45° FOV
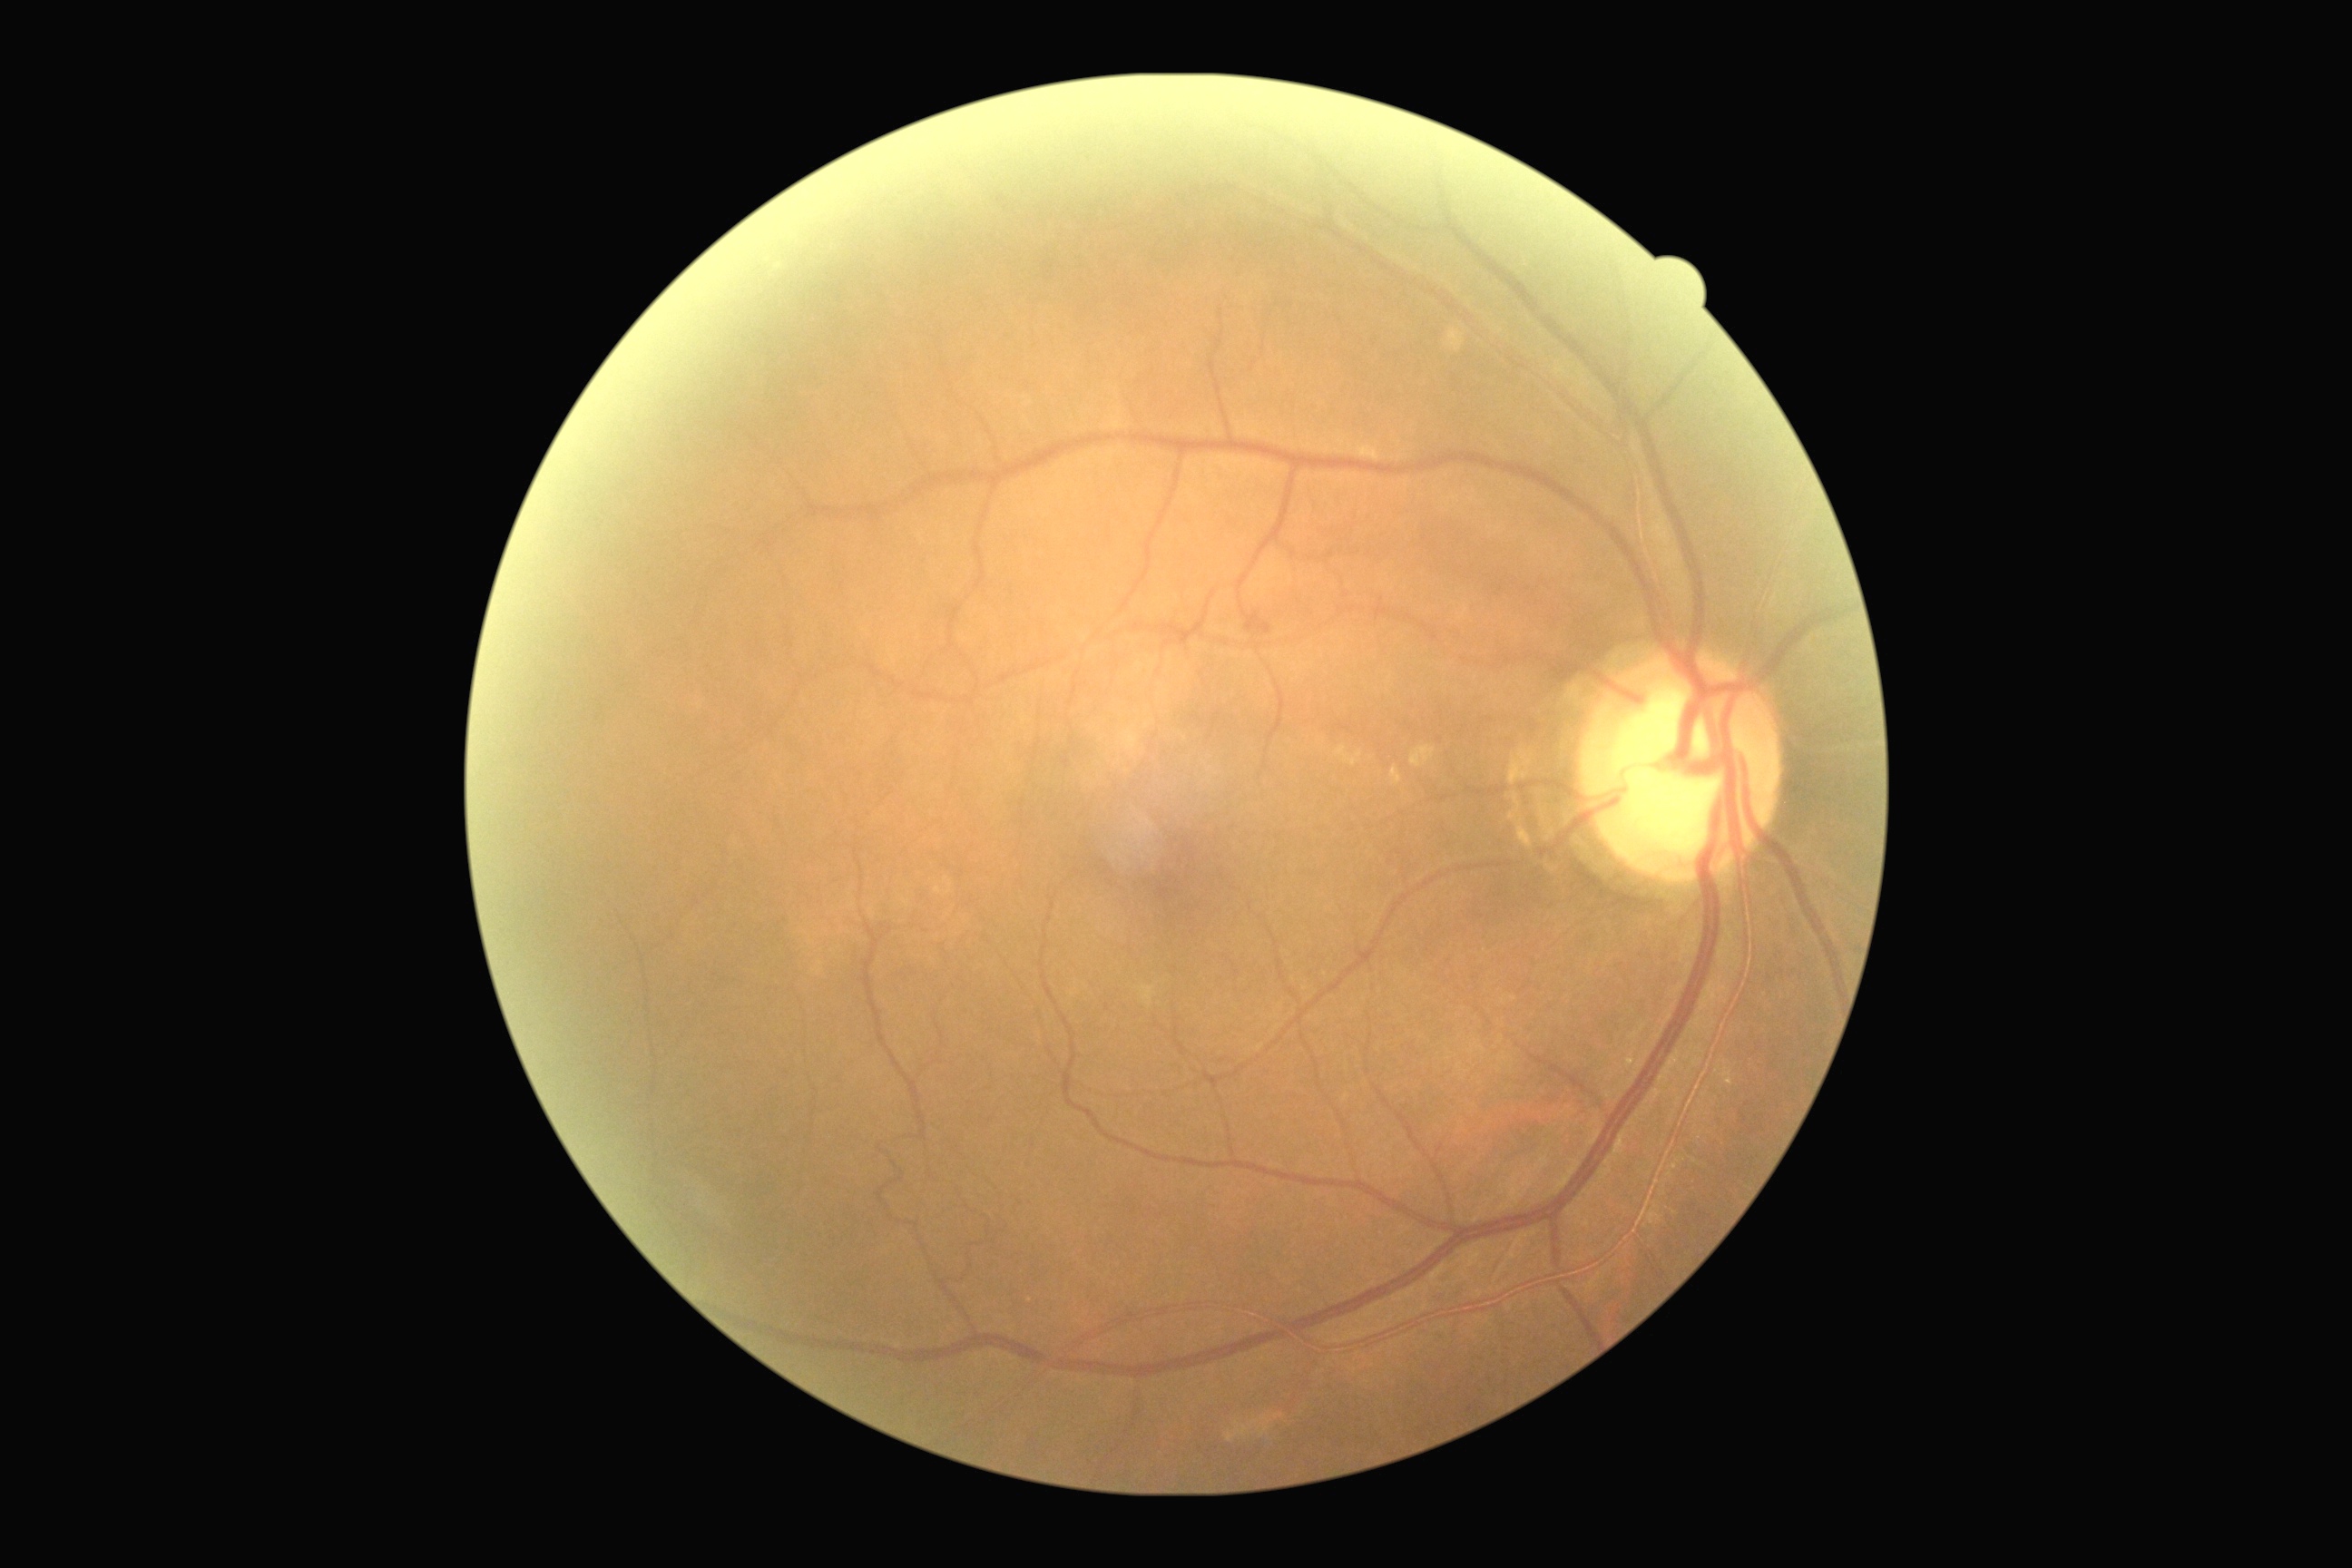
Diabetic retinopathy: moderate non-proliferative diabetic retinopathy (grade 2).